Retinal fundus photograph: 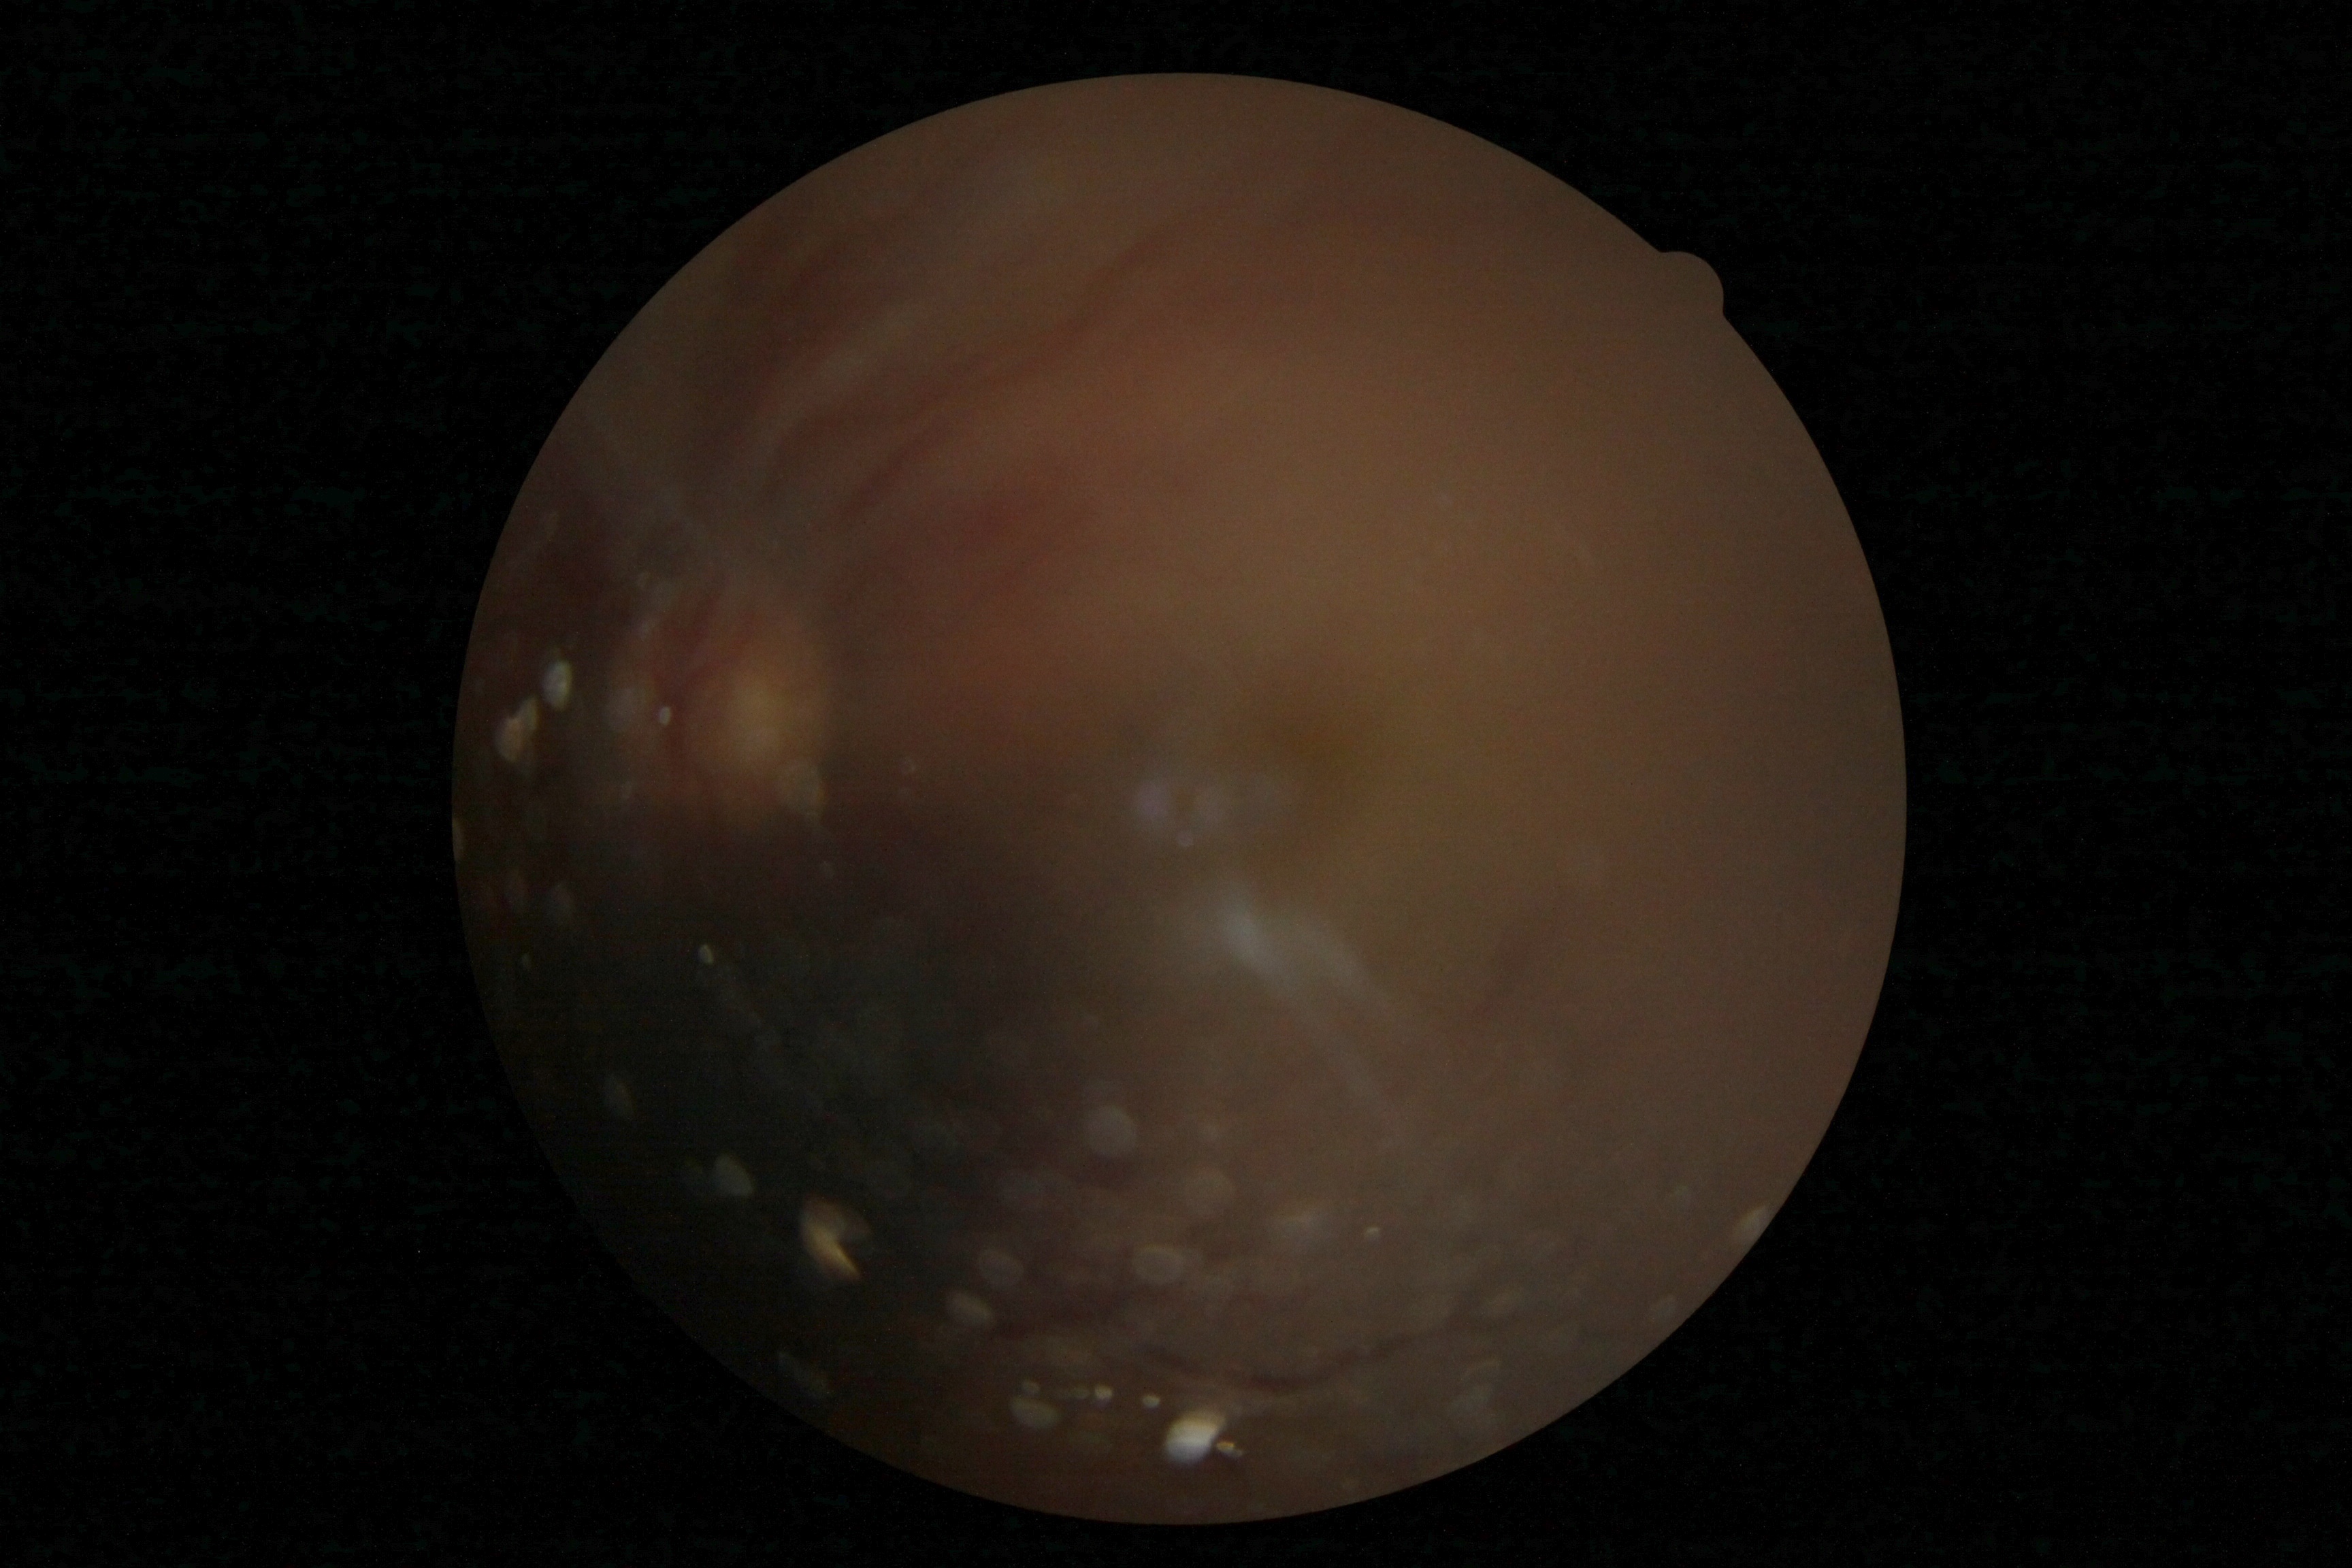
Findings:
- image quality — insufficient for DR assessment
- DR grade — ungradable due to poor image quality